Tabletop color fundus camera image, 1924 by 1556 pixels, FOV: 50 degrees: 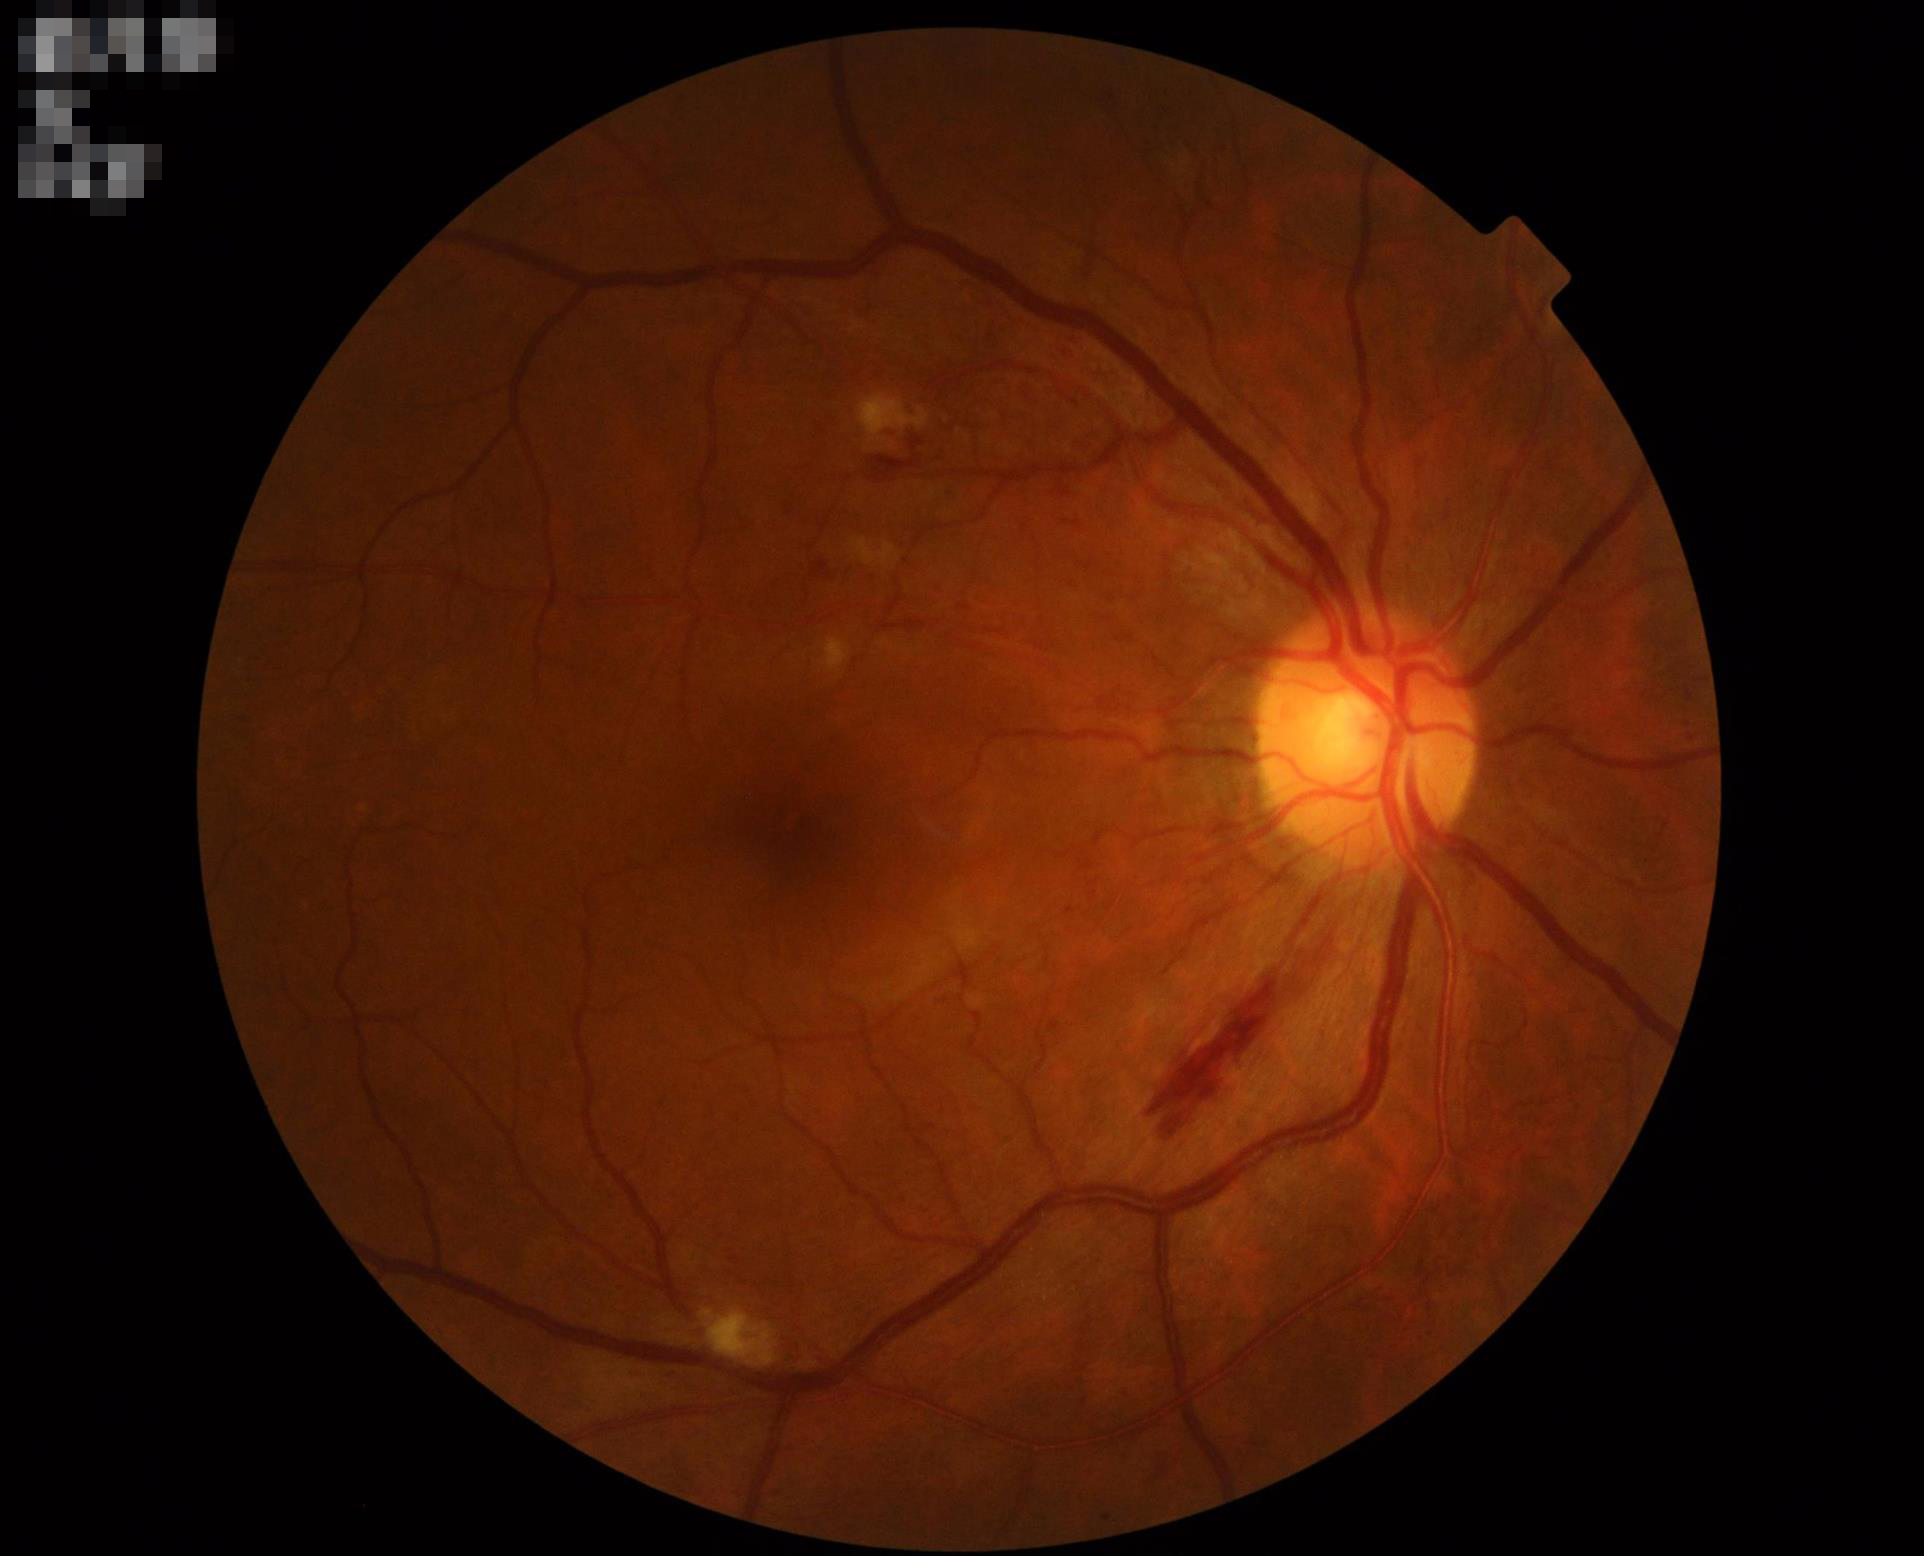
Quality grading:
- sharpness: clear with no noticeable blur
- overall: good and suitable for diagnostic use